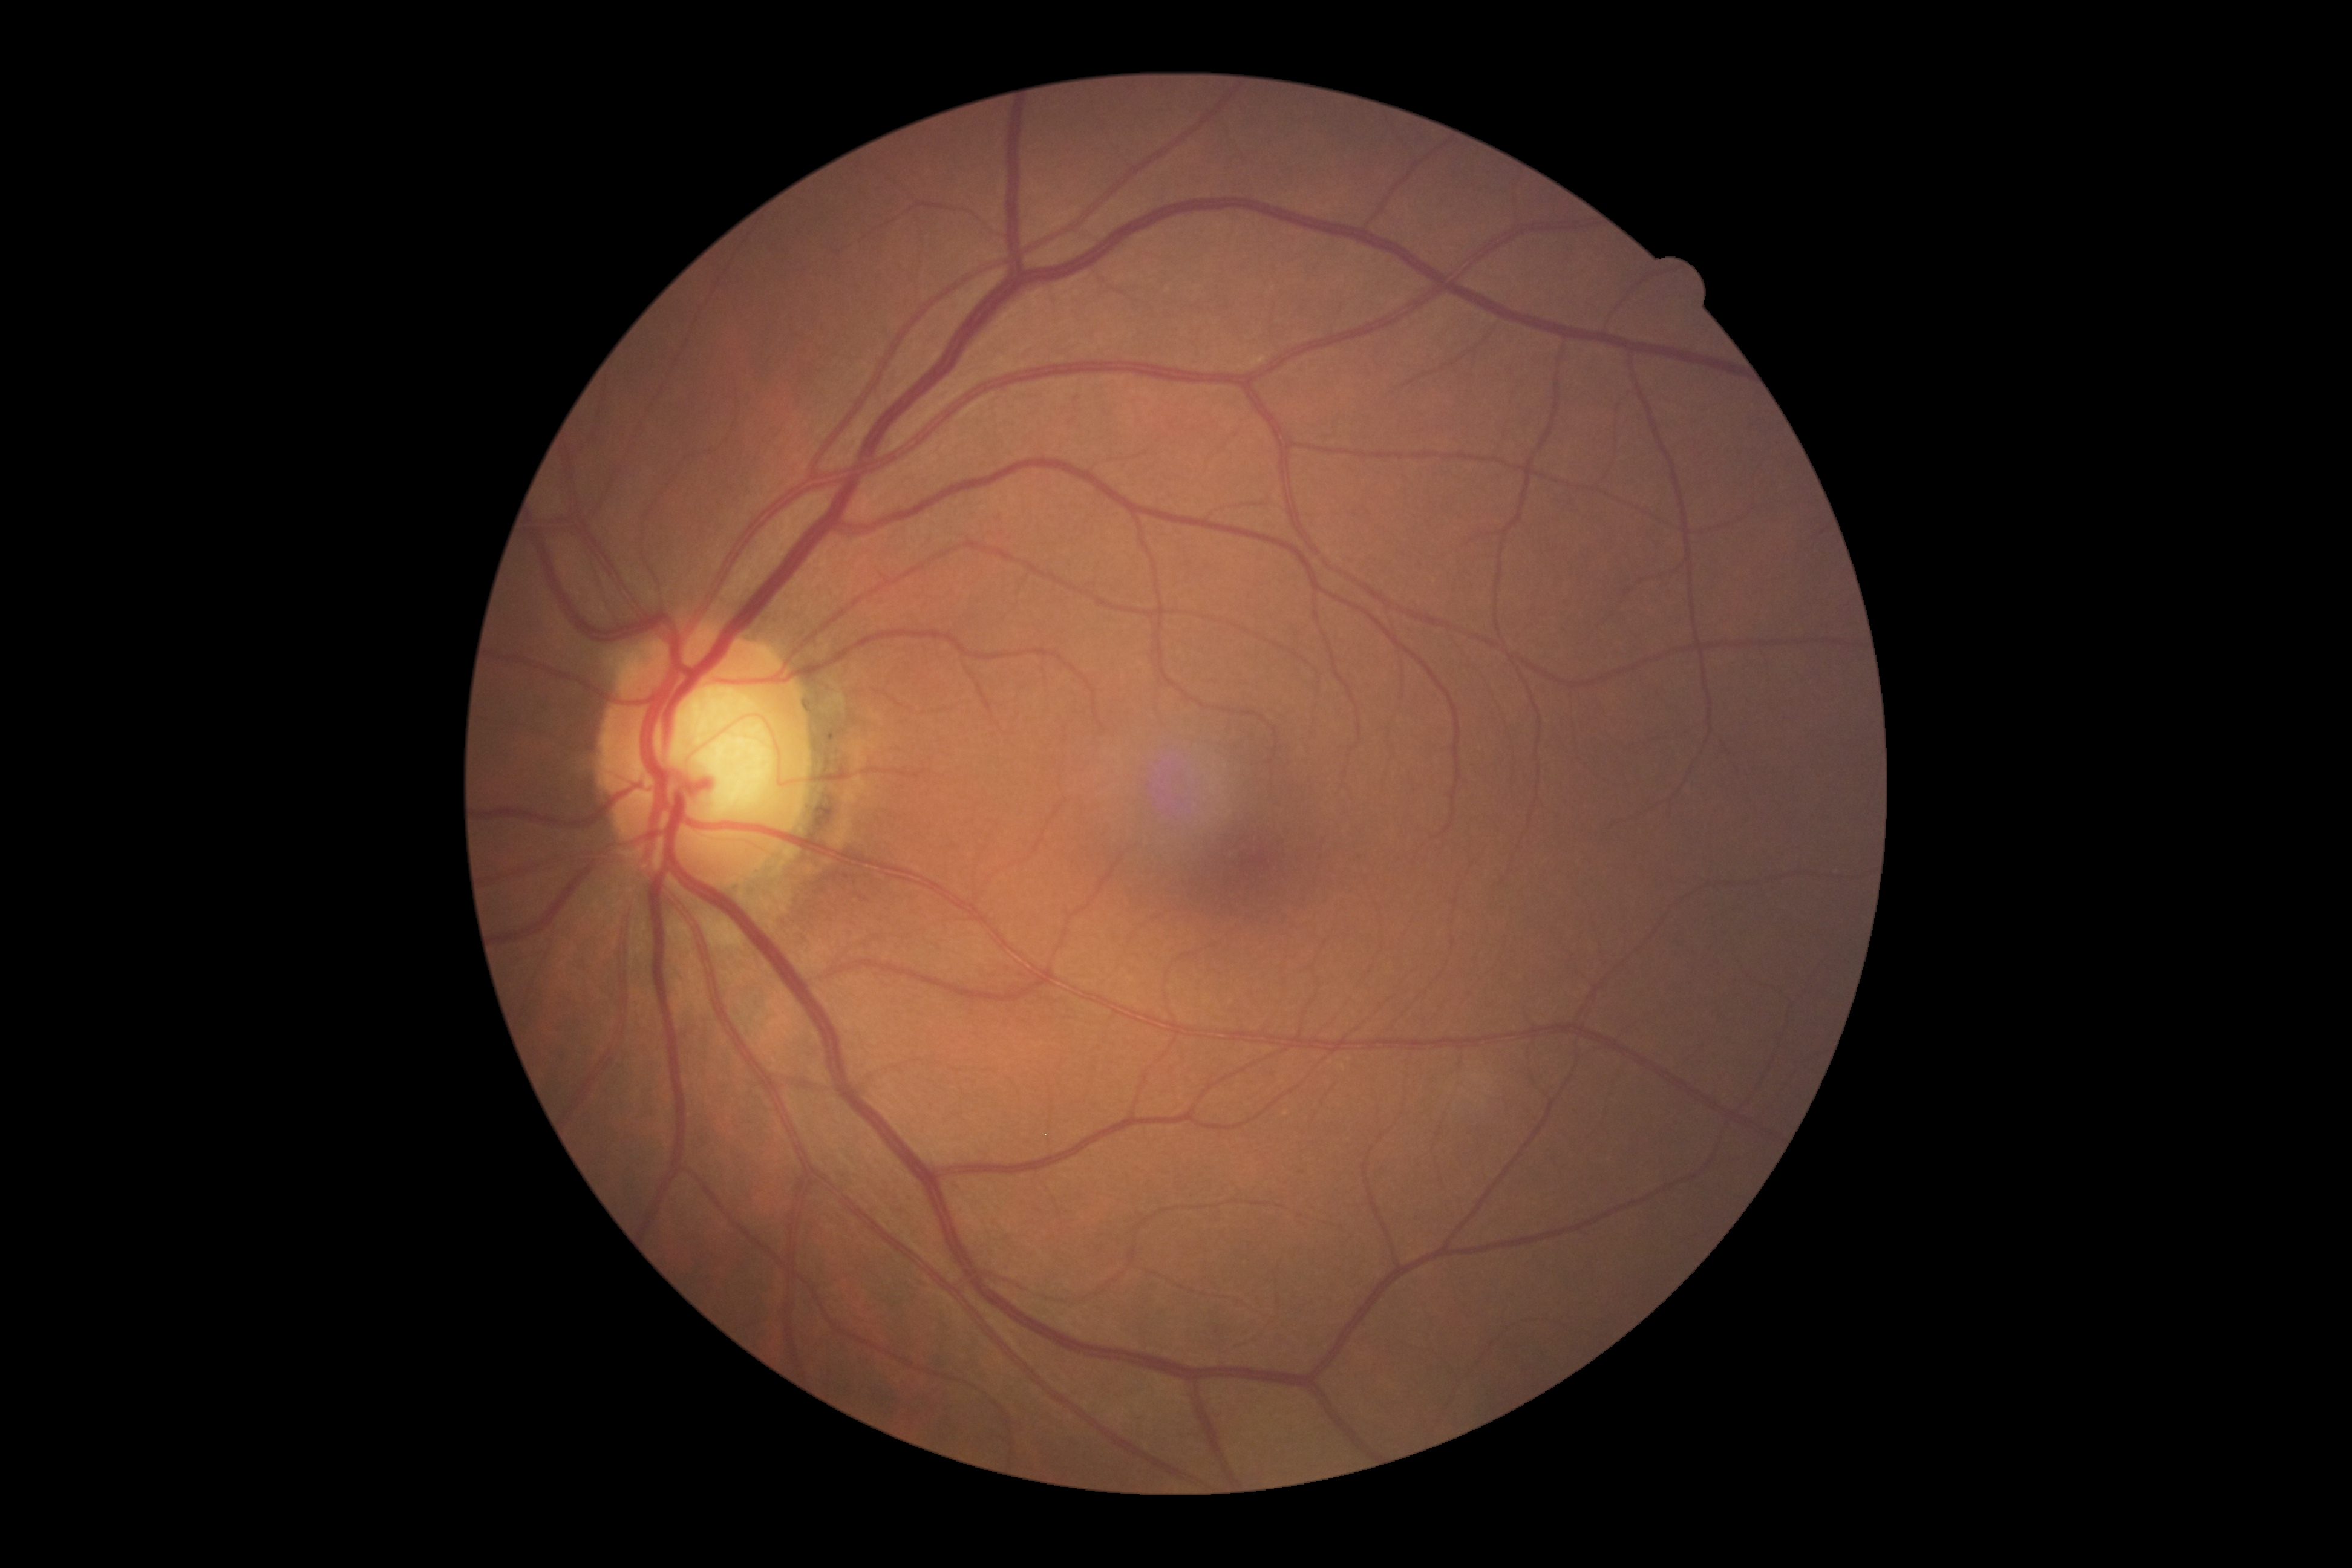
diabetic retinopathy: grade 0 (no apparent retinopathy) — no visible signs of diabetic retinopathy.